Wide-field fundus photograph of an infant — 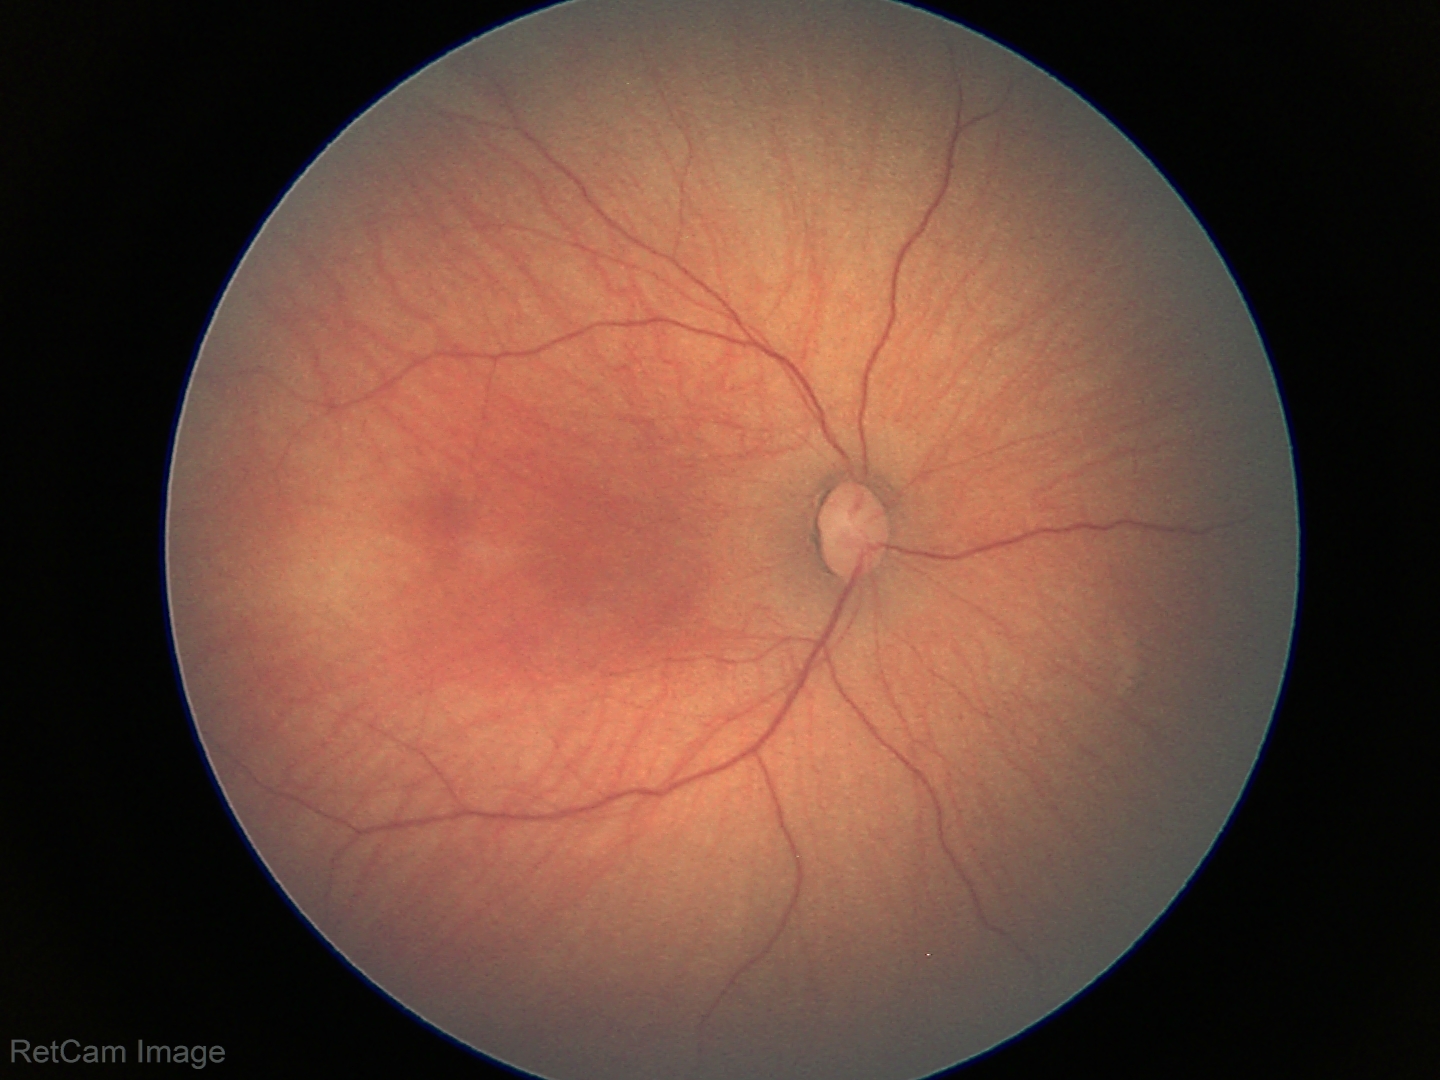
No retinal pathology identified on screening.